Fundus photo
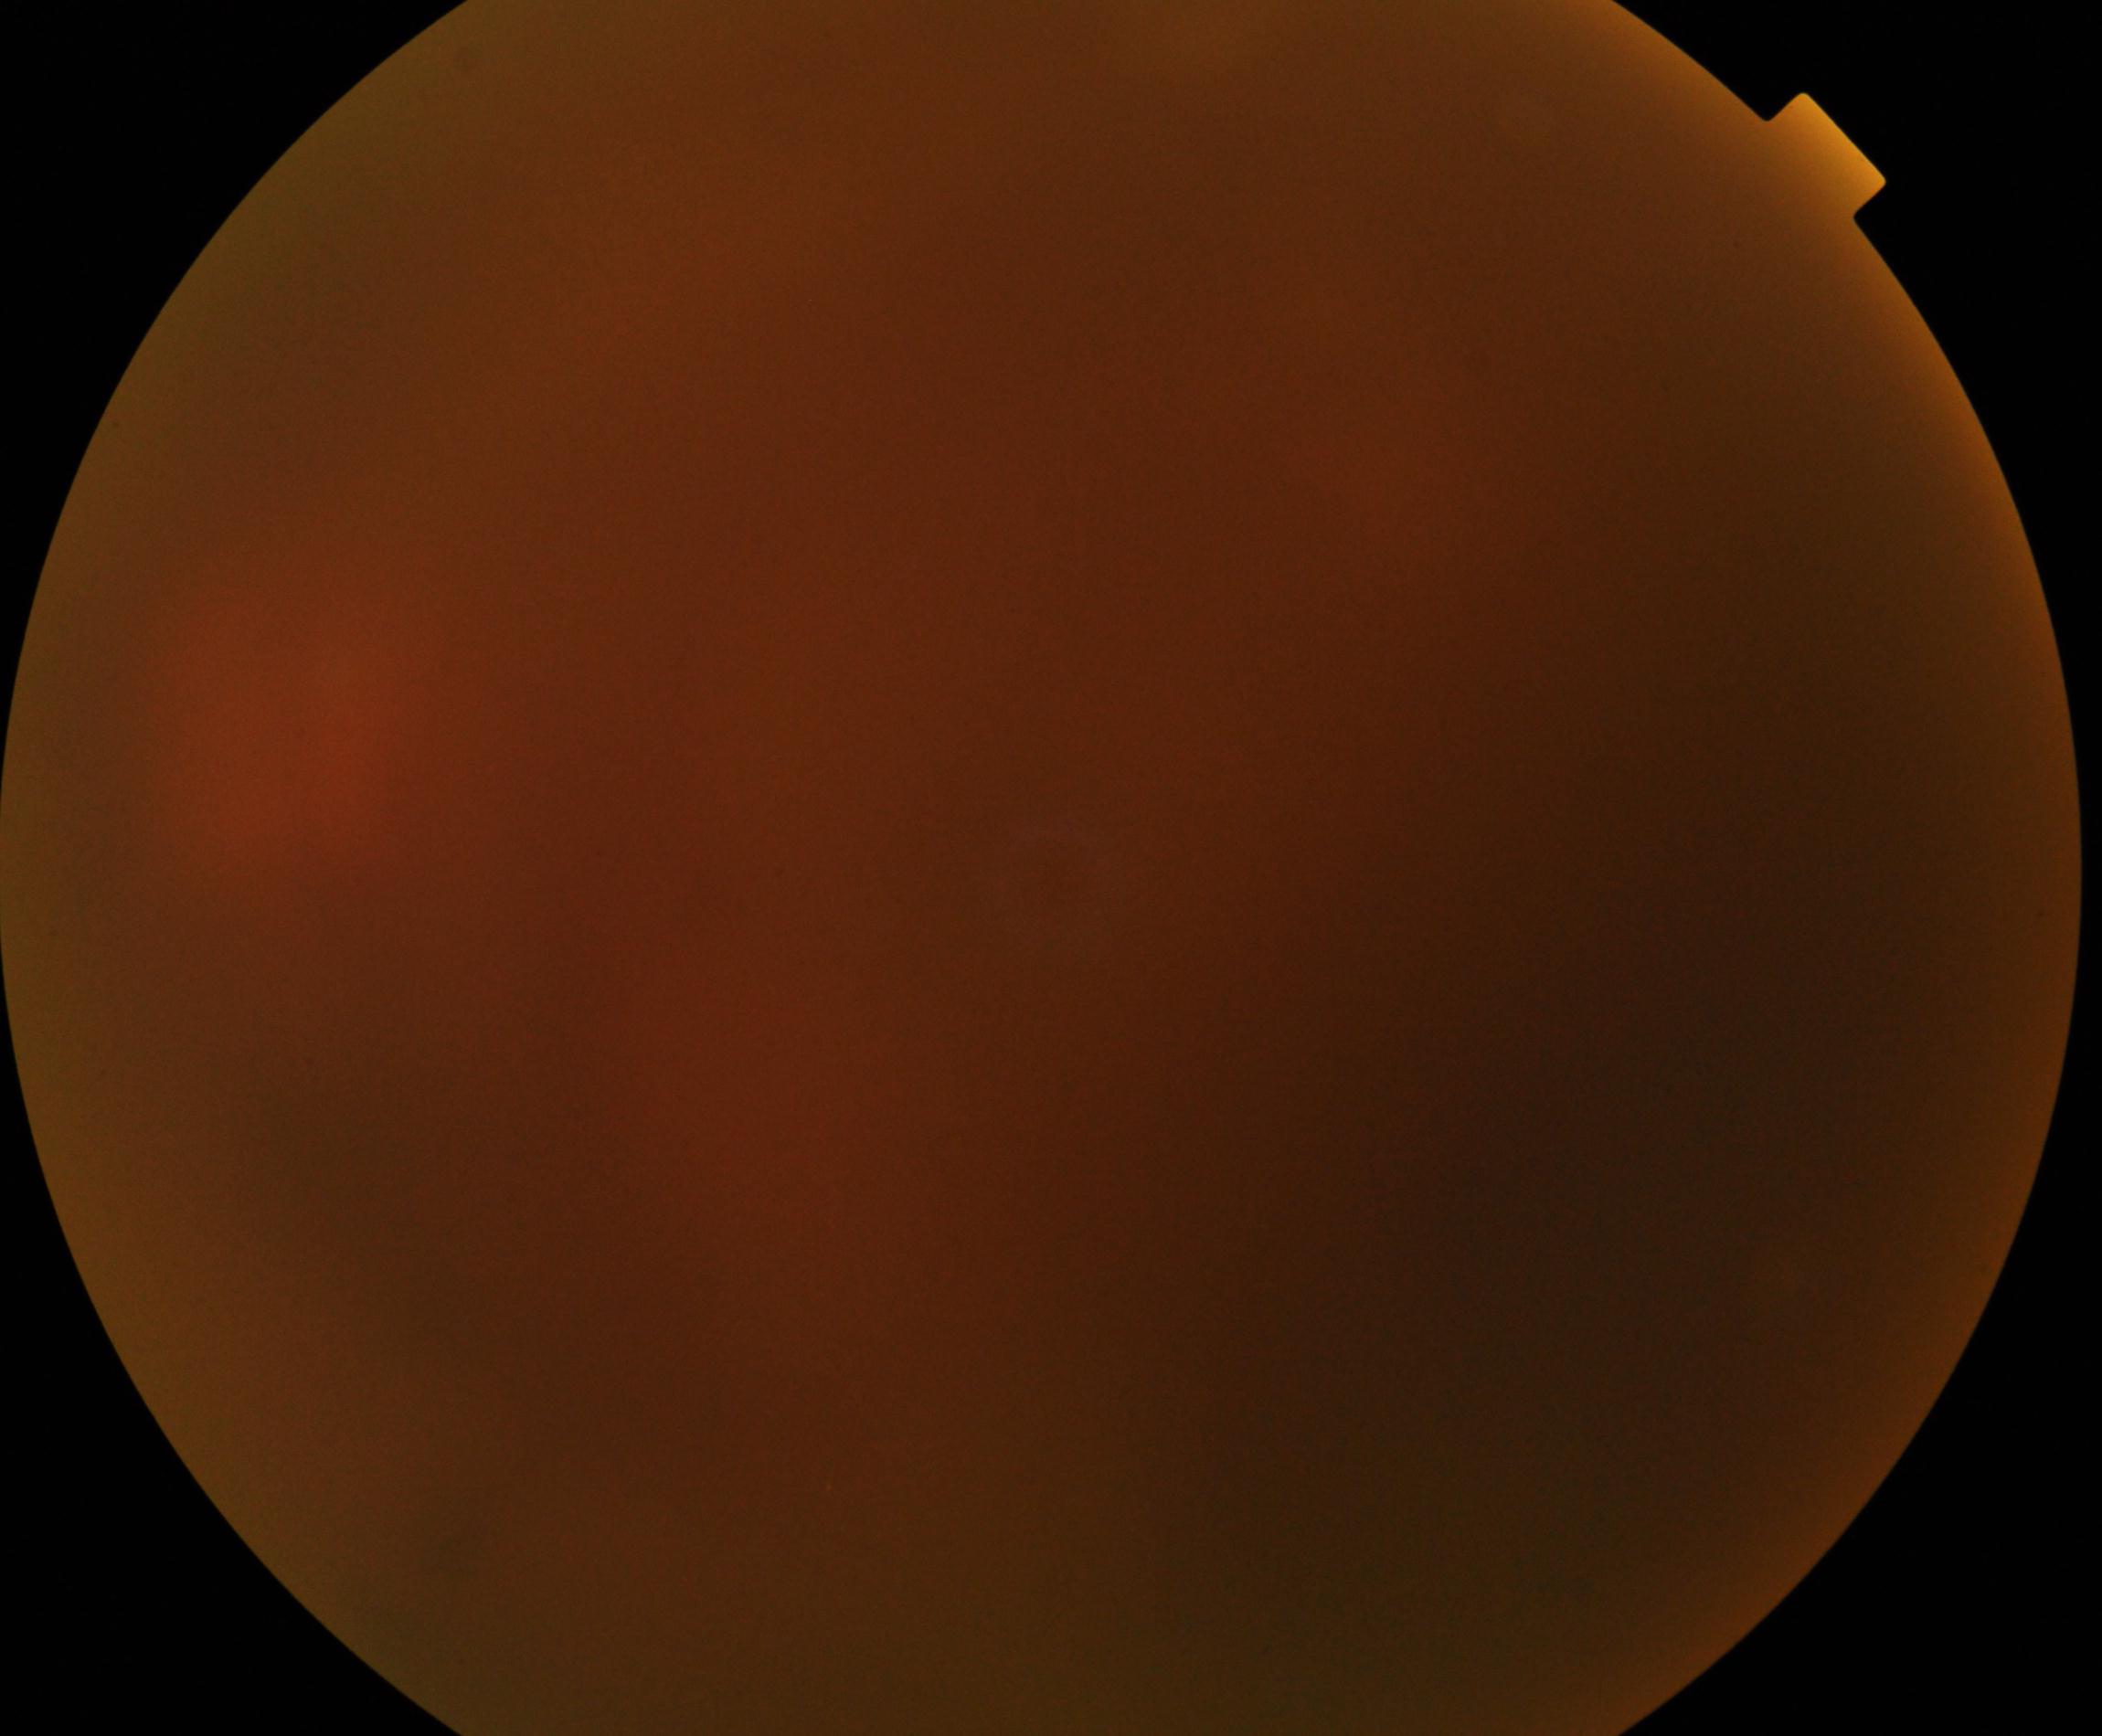 Image is blurred; retinal landmarks are largely obscured. No evidence of proliferative diabetic retinopathy.